Davis DR grading; 848 x 848 pixels; camera: NIDEK AFC-230; 45 degree fundus photograph — 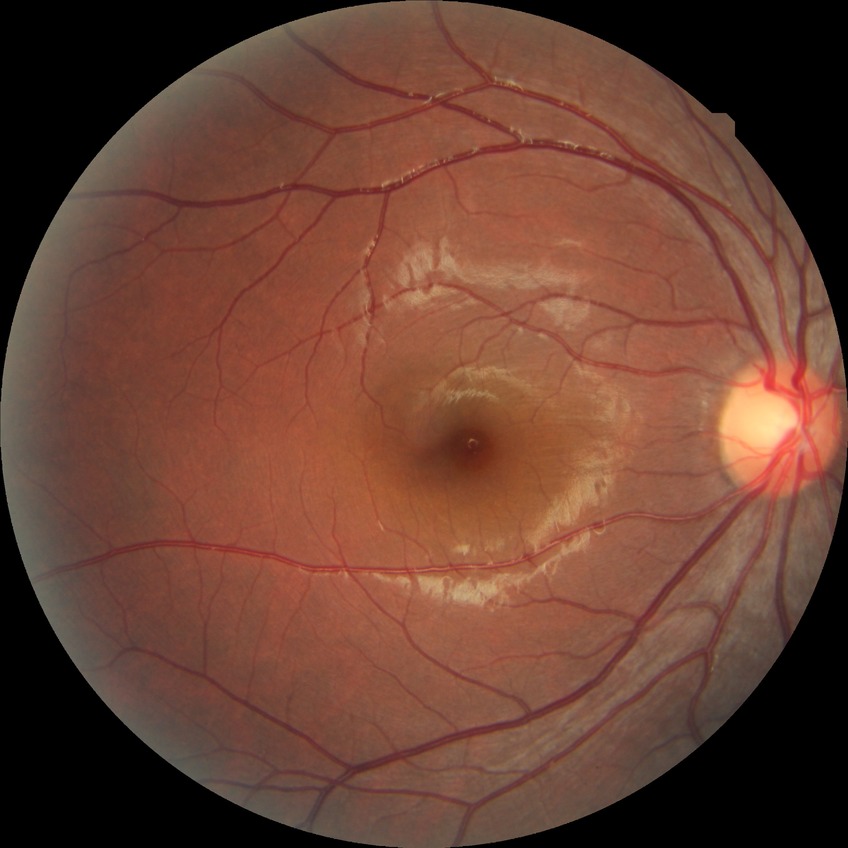
diabetic retinopathy (DR): no diabetic retinopathy (NDR).